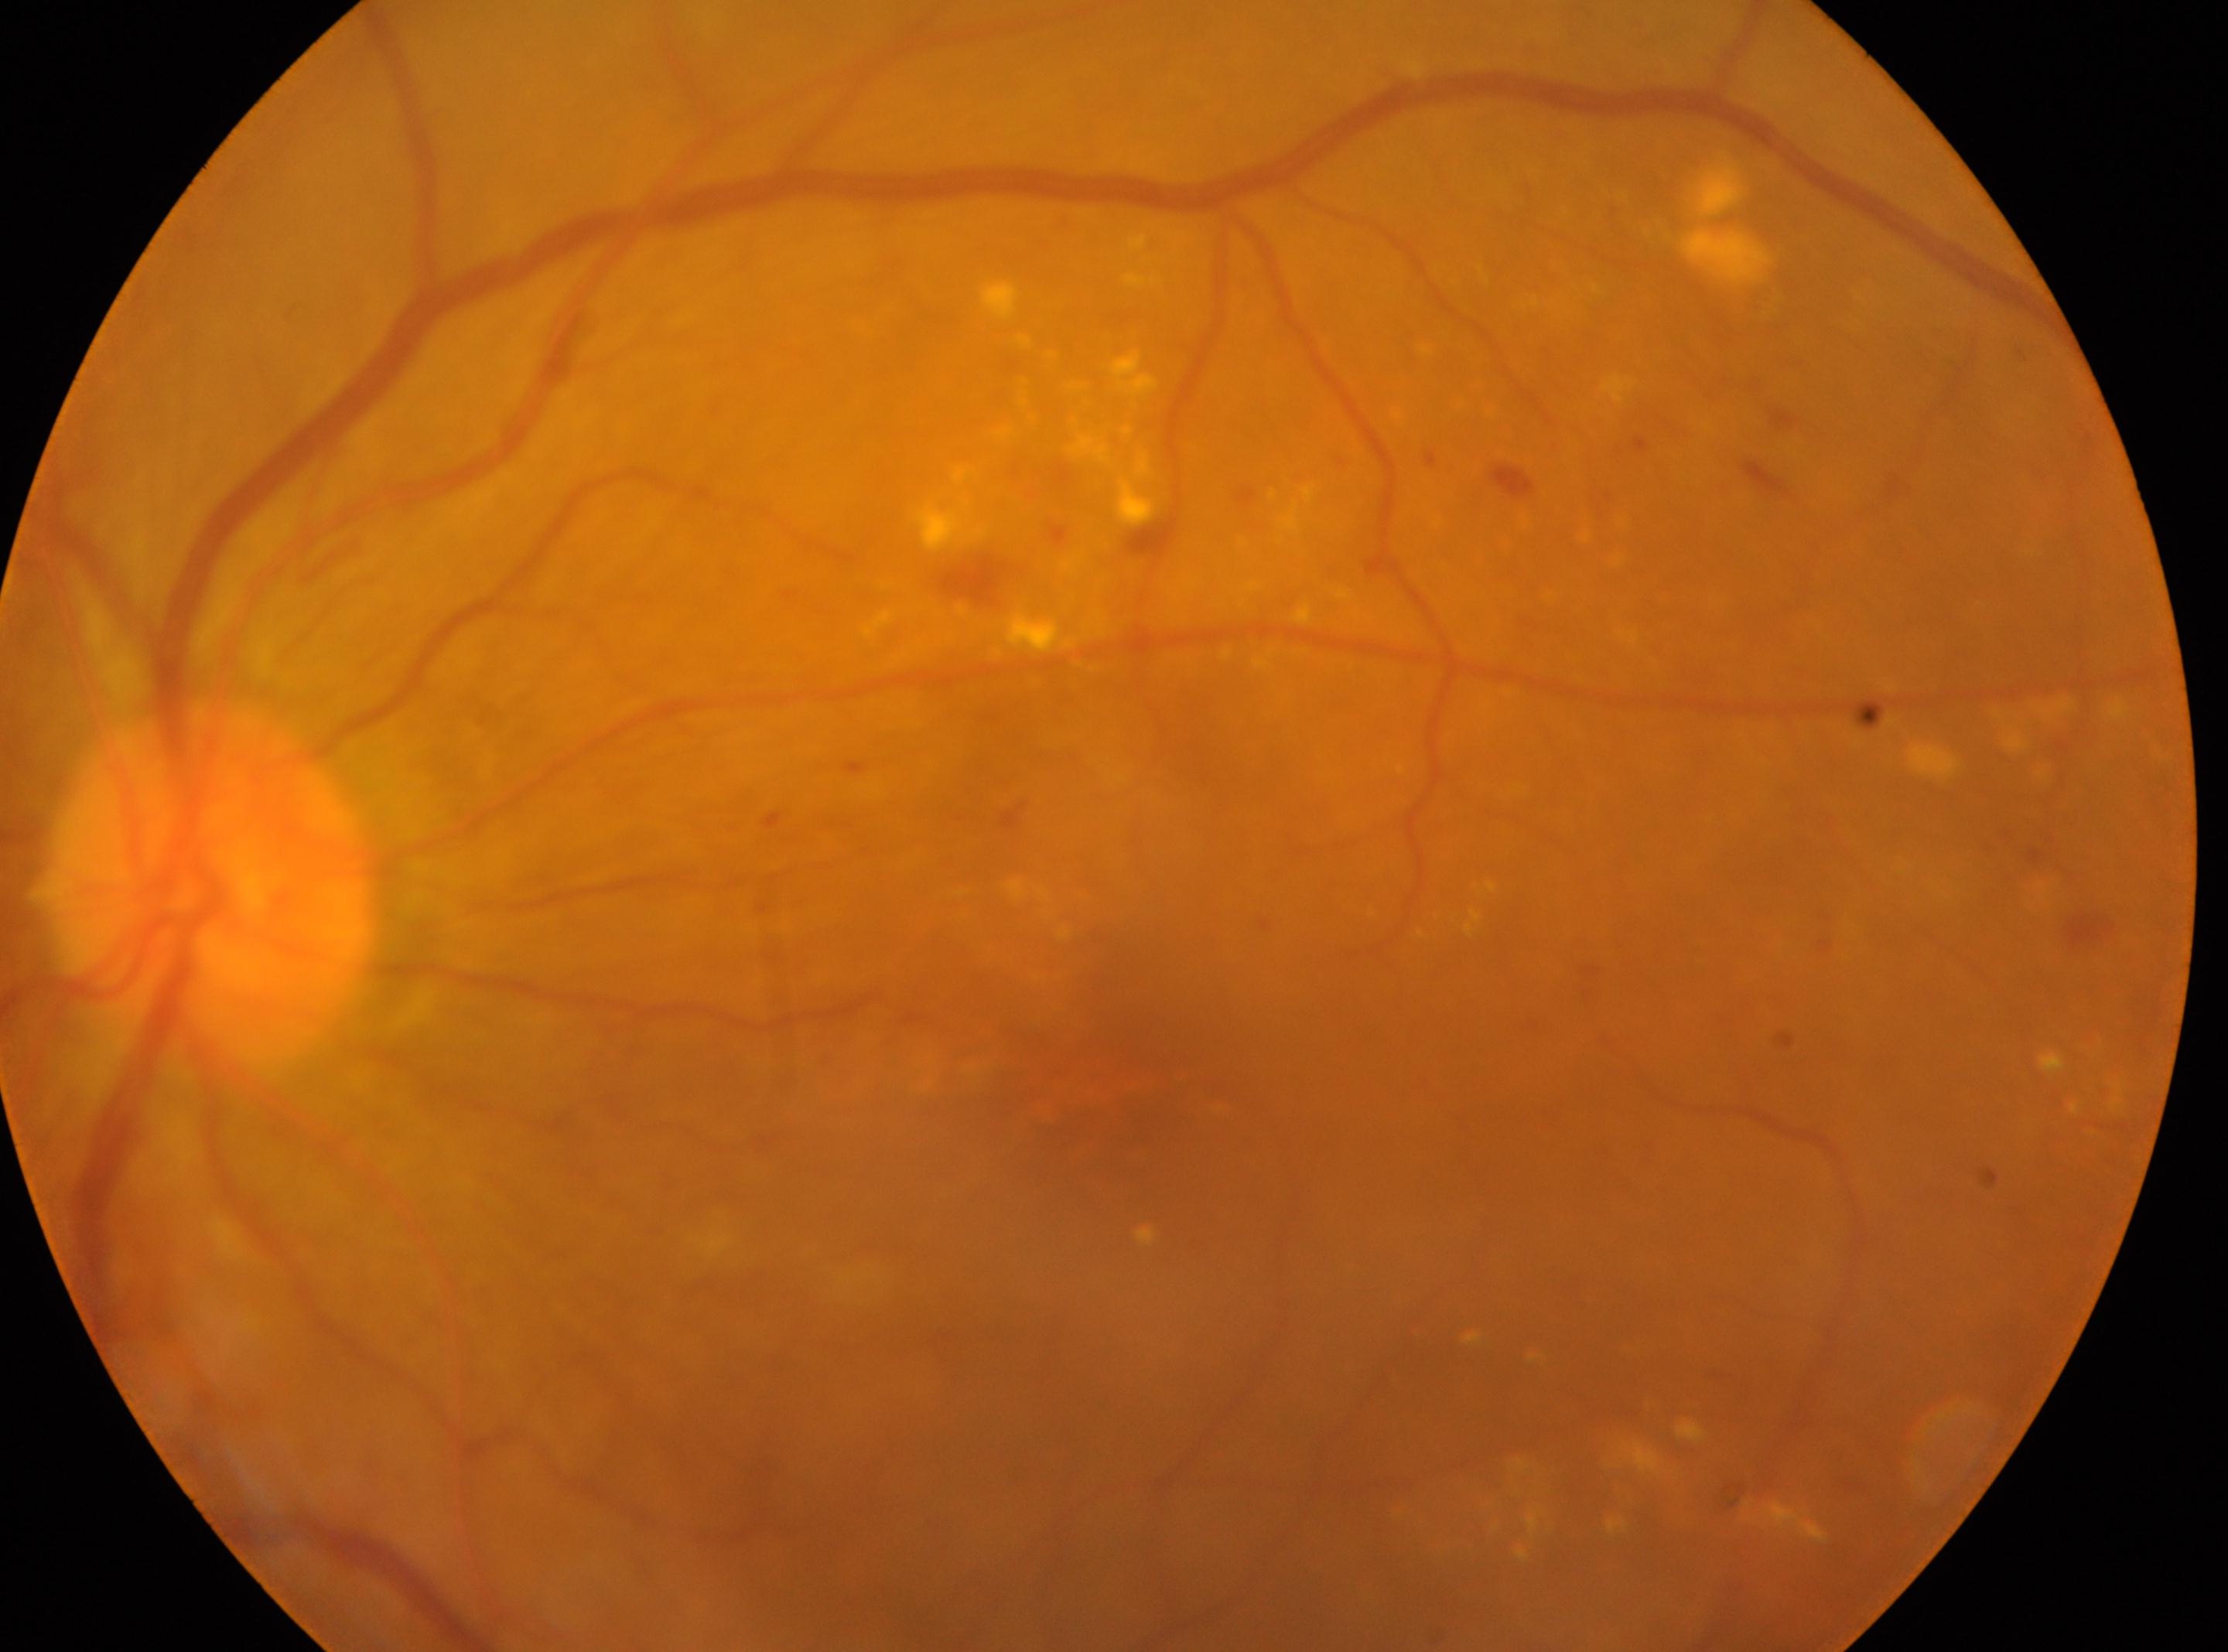

Findings:
– eye: OS
– diabetic retinopathy grade: 2
– optic disc: (x: 209, y: 892)
– the fovea: (x: 1082, y: 1098)